Fundus photo · centered on the optic disc
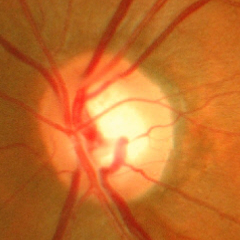
Advanced glaucomatous optic neuropathy.